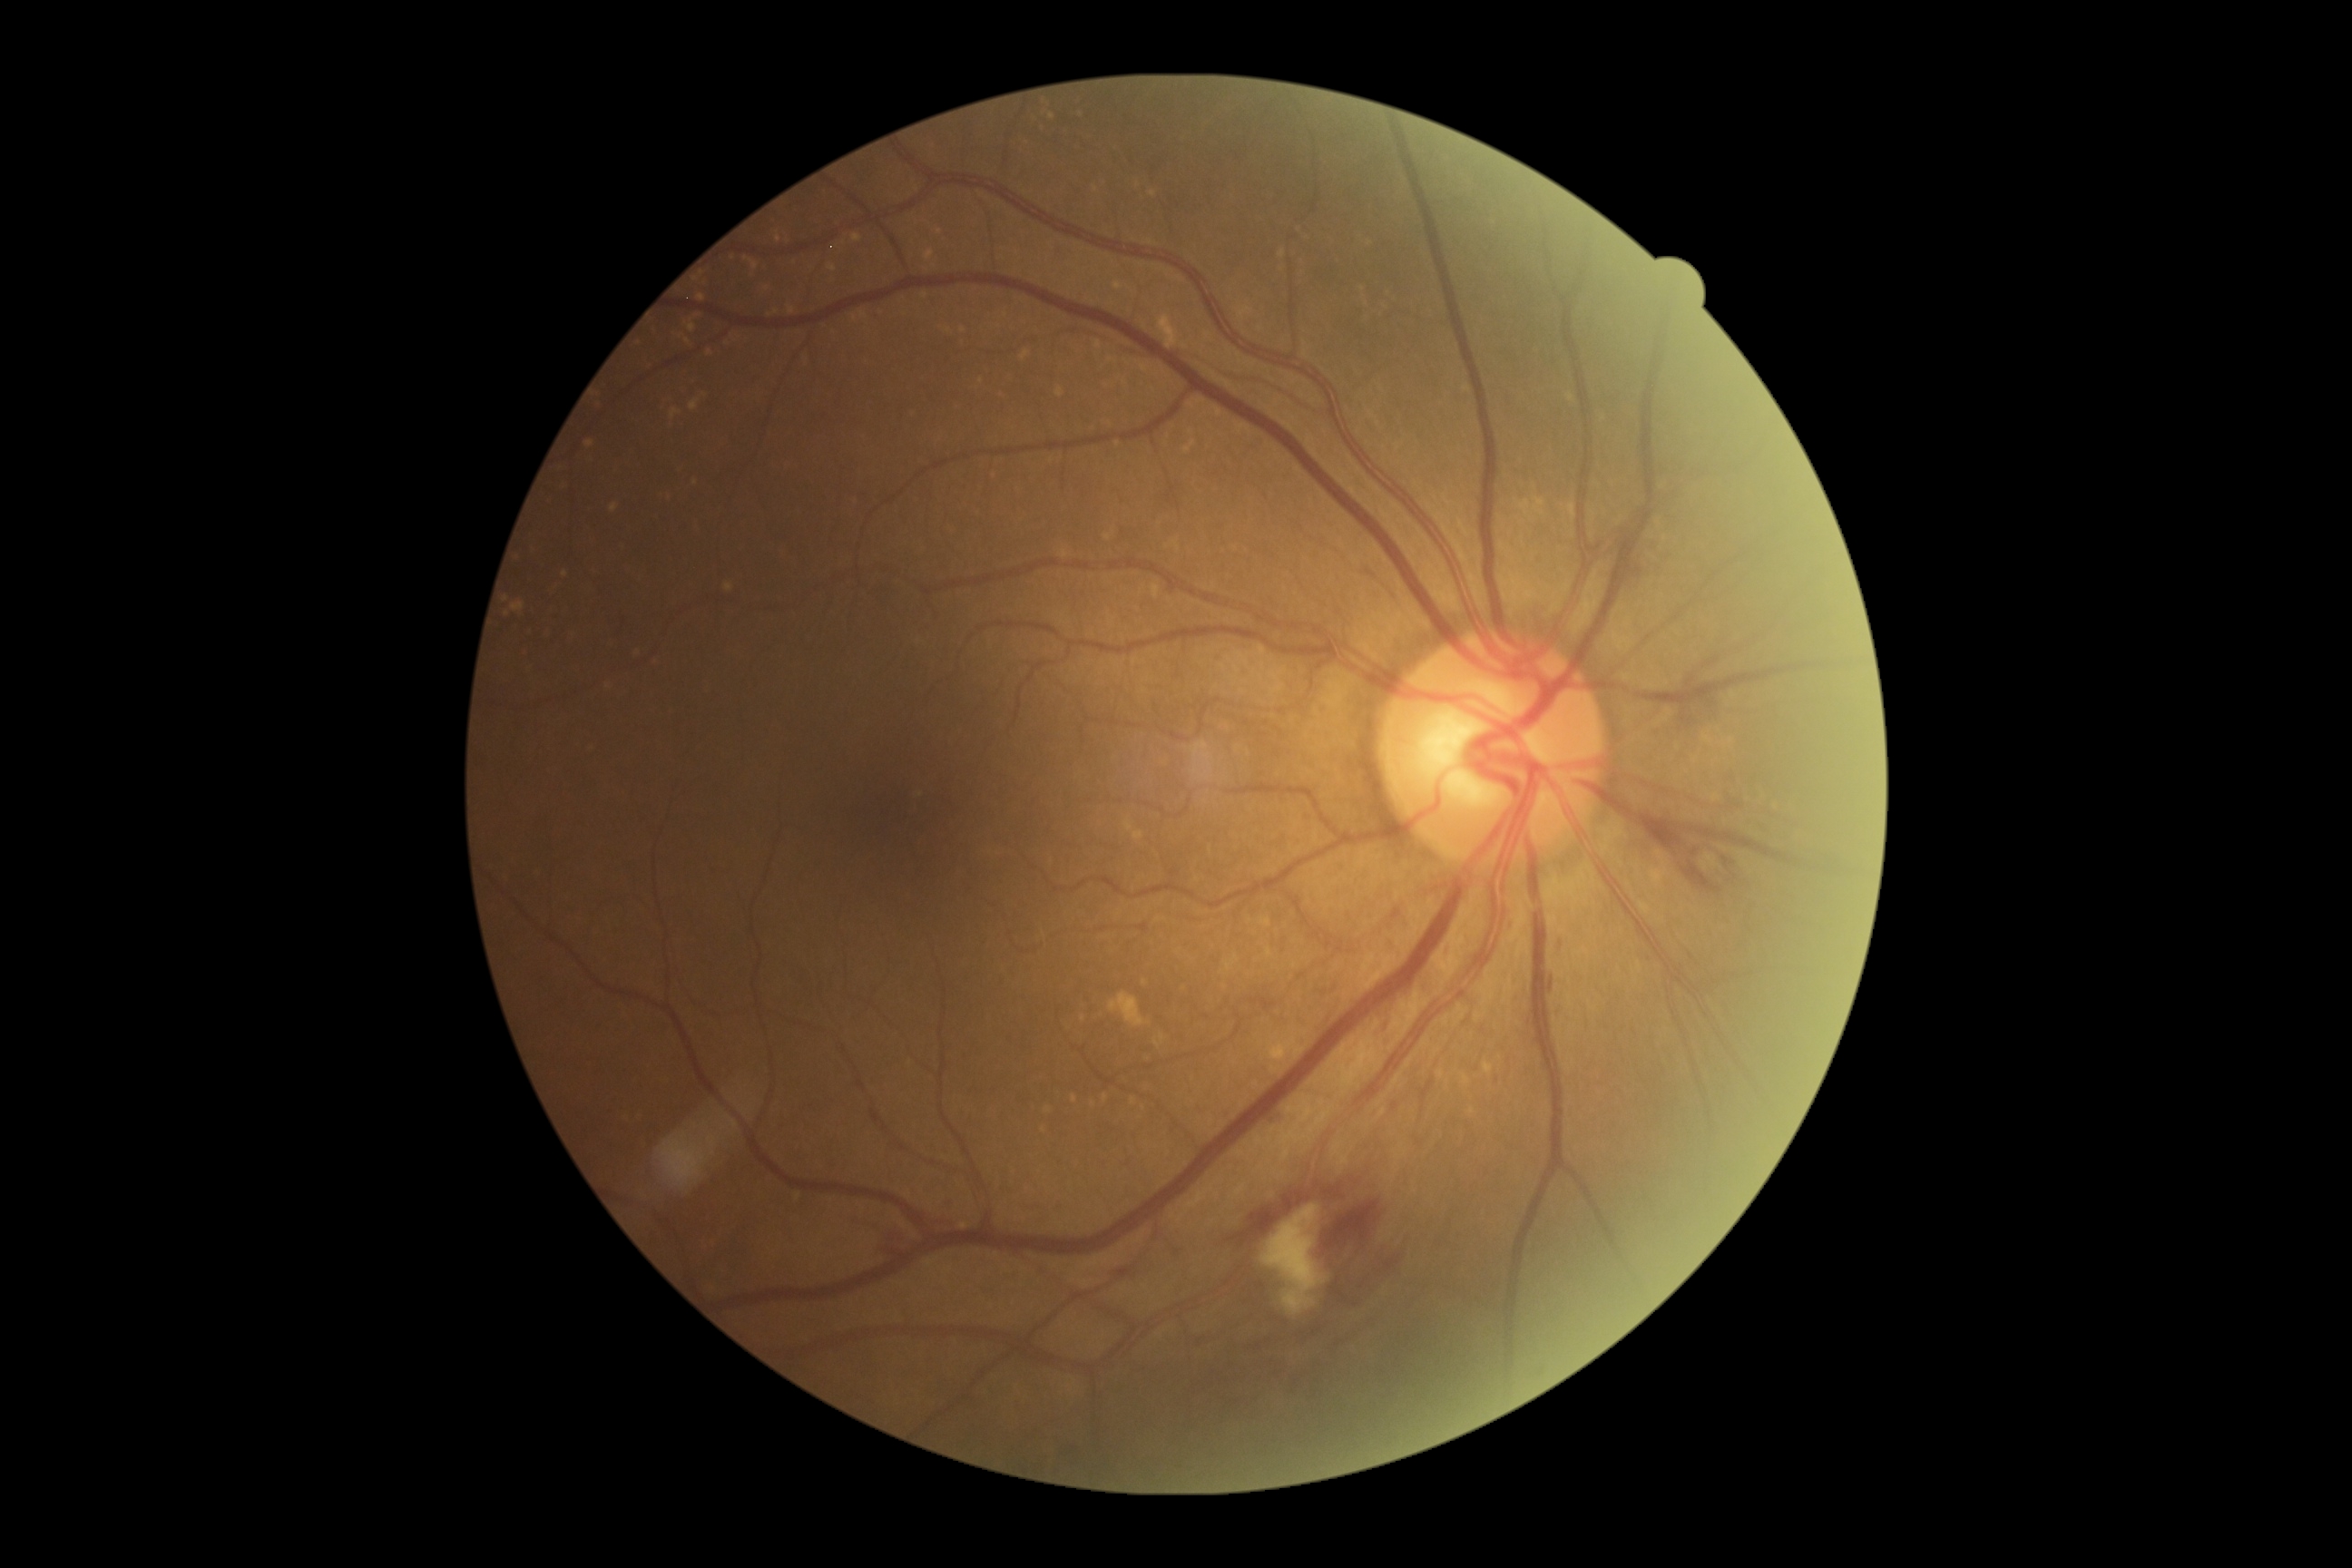

Diabetic retinopathy (DR): 2
microaneurysms (MAs): 1068,1446,1079,1458; 1275,1108,1291,1126; 1382,1019,1391,1028; 1446,948,1451,957
Additional small MAs near <pt>1496,1082</pt>
hard exudates (EXs): not present
hemorrhages (HEs): 1230,1173,1348,1246; 1315,1199,1380,1262; 1649,819,1730,894; 874,1226,912,1259; 1674,696,1718,729; 1551,977,1554,994; 1329,1248,1402,1309; 1556,937,1565,957; 1723,772,1740,787; 946,1202,952,1211
soft exudates (SEs): 1260,1204,1326,1315